2352 by 1568 pixels — 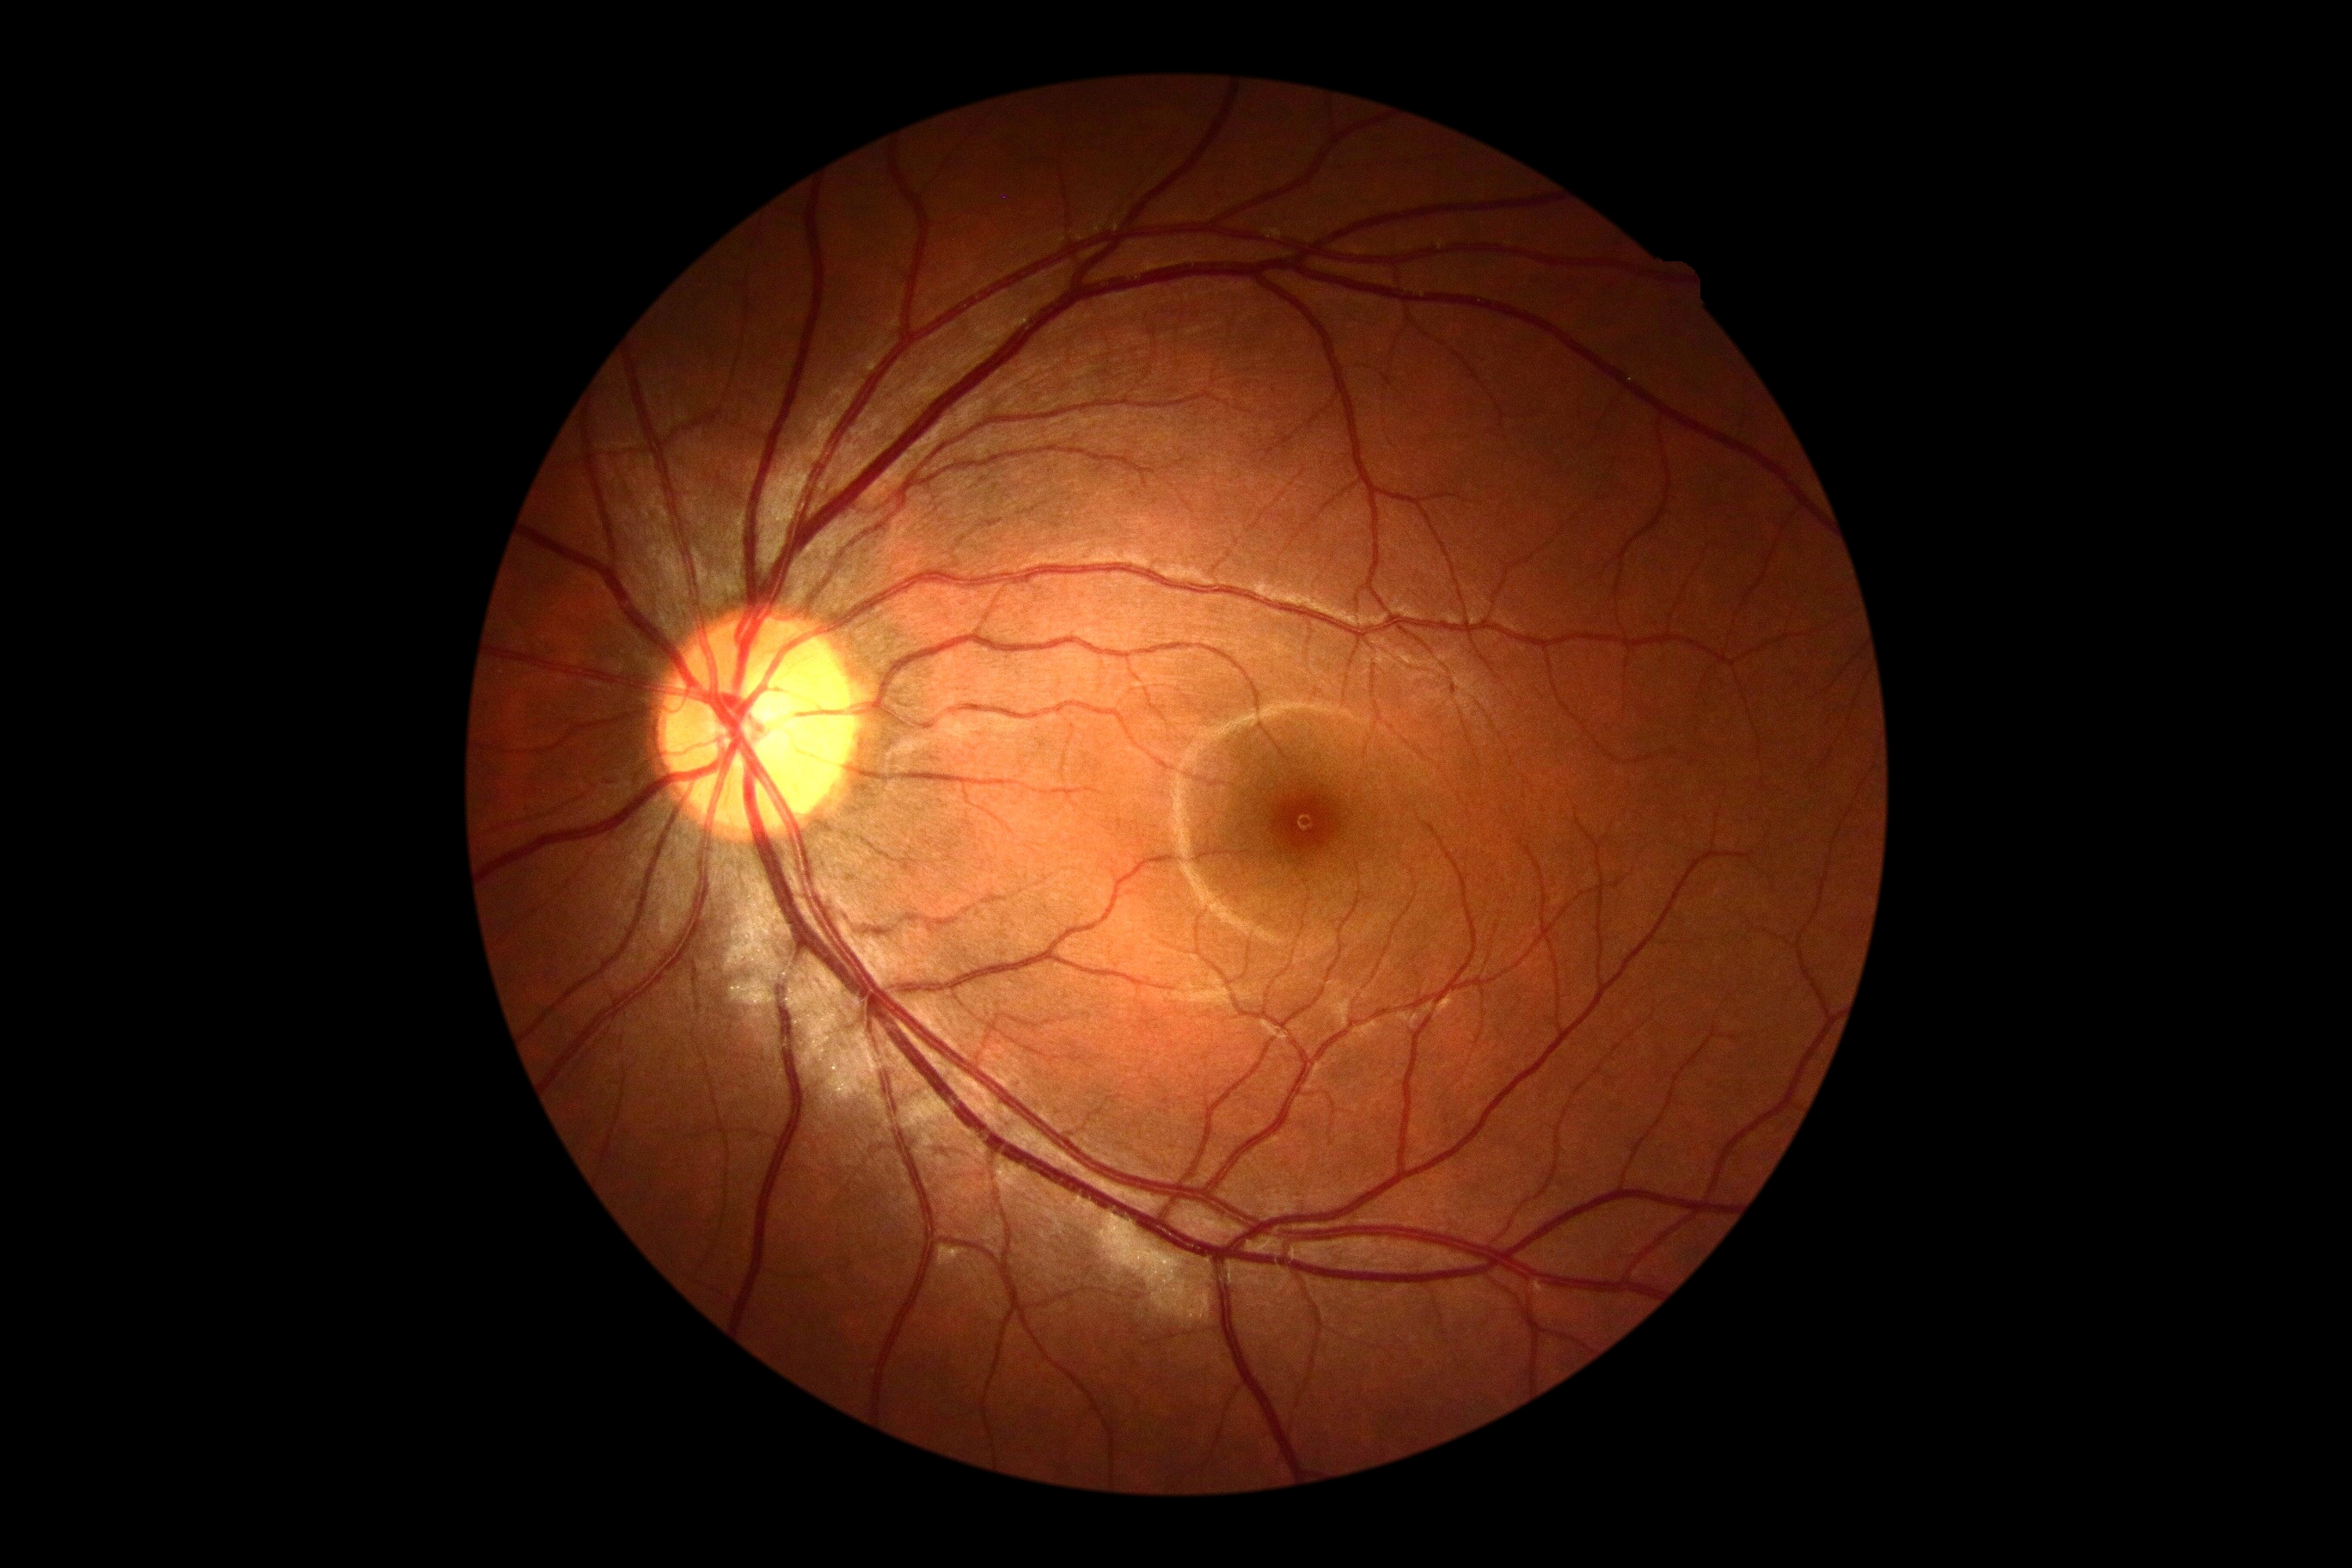 No signs of diabetic retinopathy.
Diabetic retinopathy is no apparent retinopathy (grade 0).